1932x1916px. Color fundus photograph. FOV: 45 degrees: 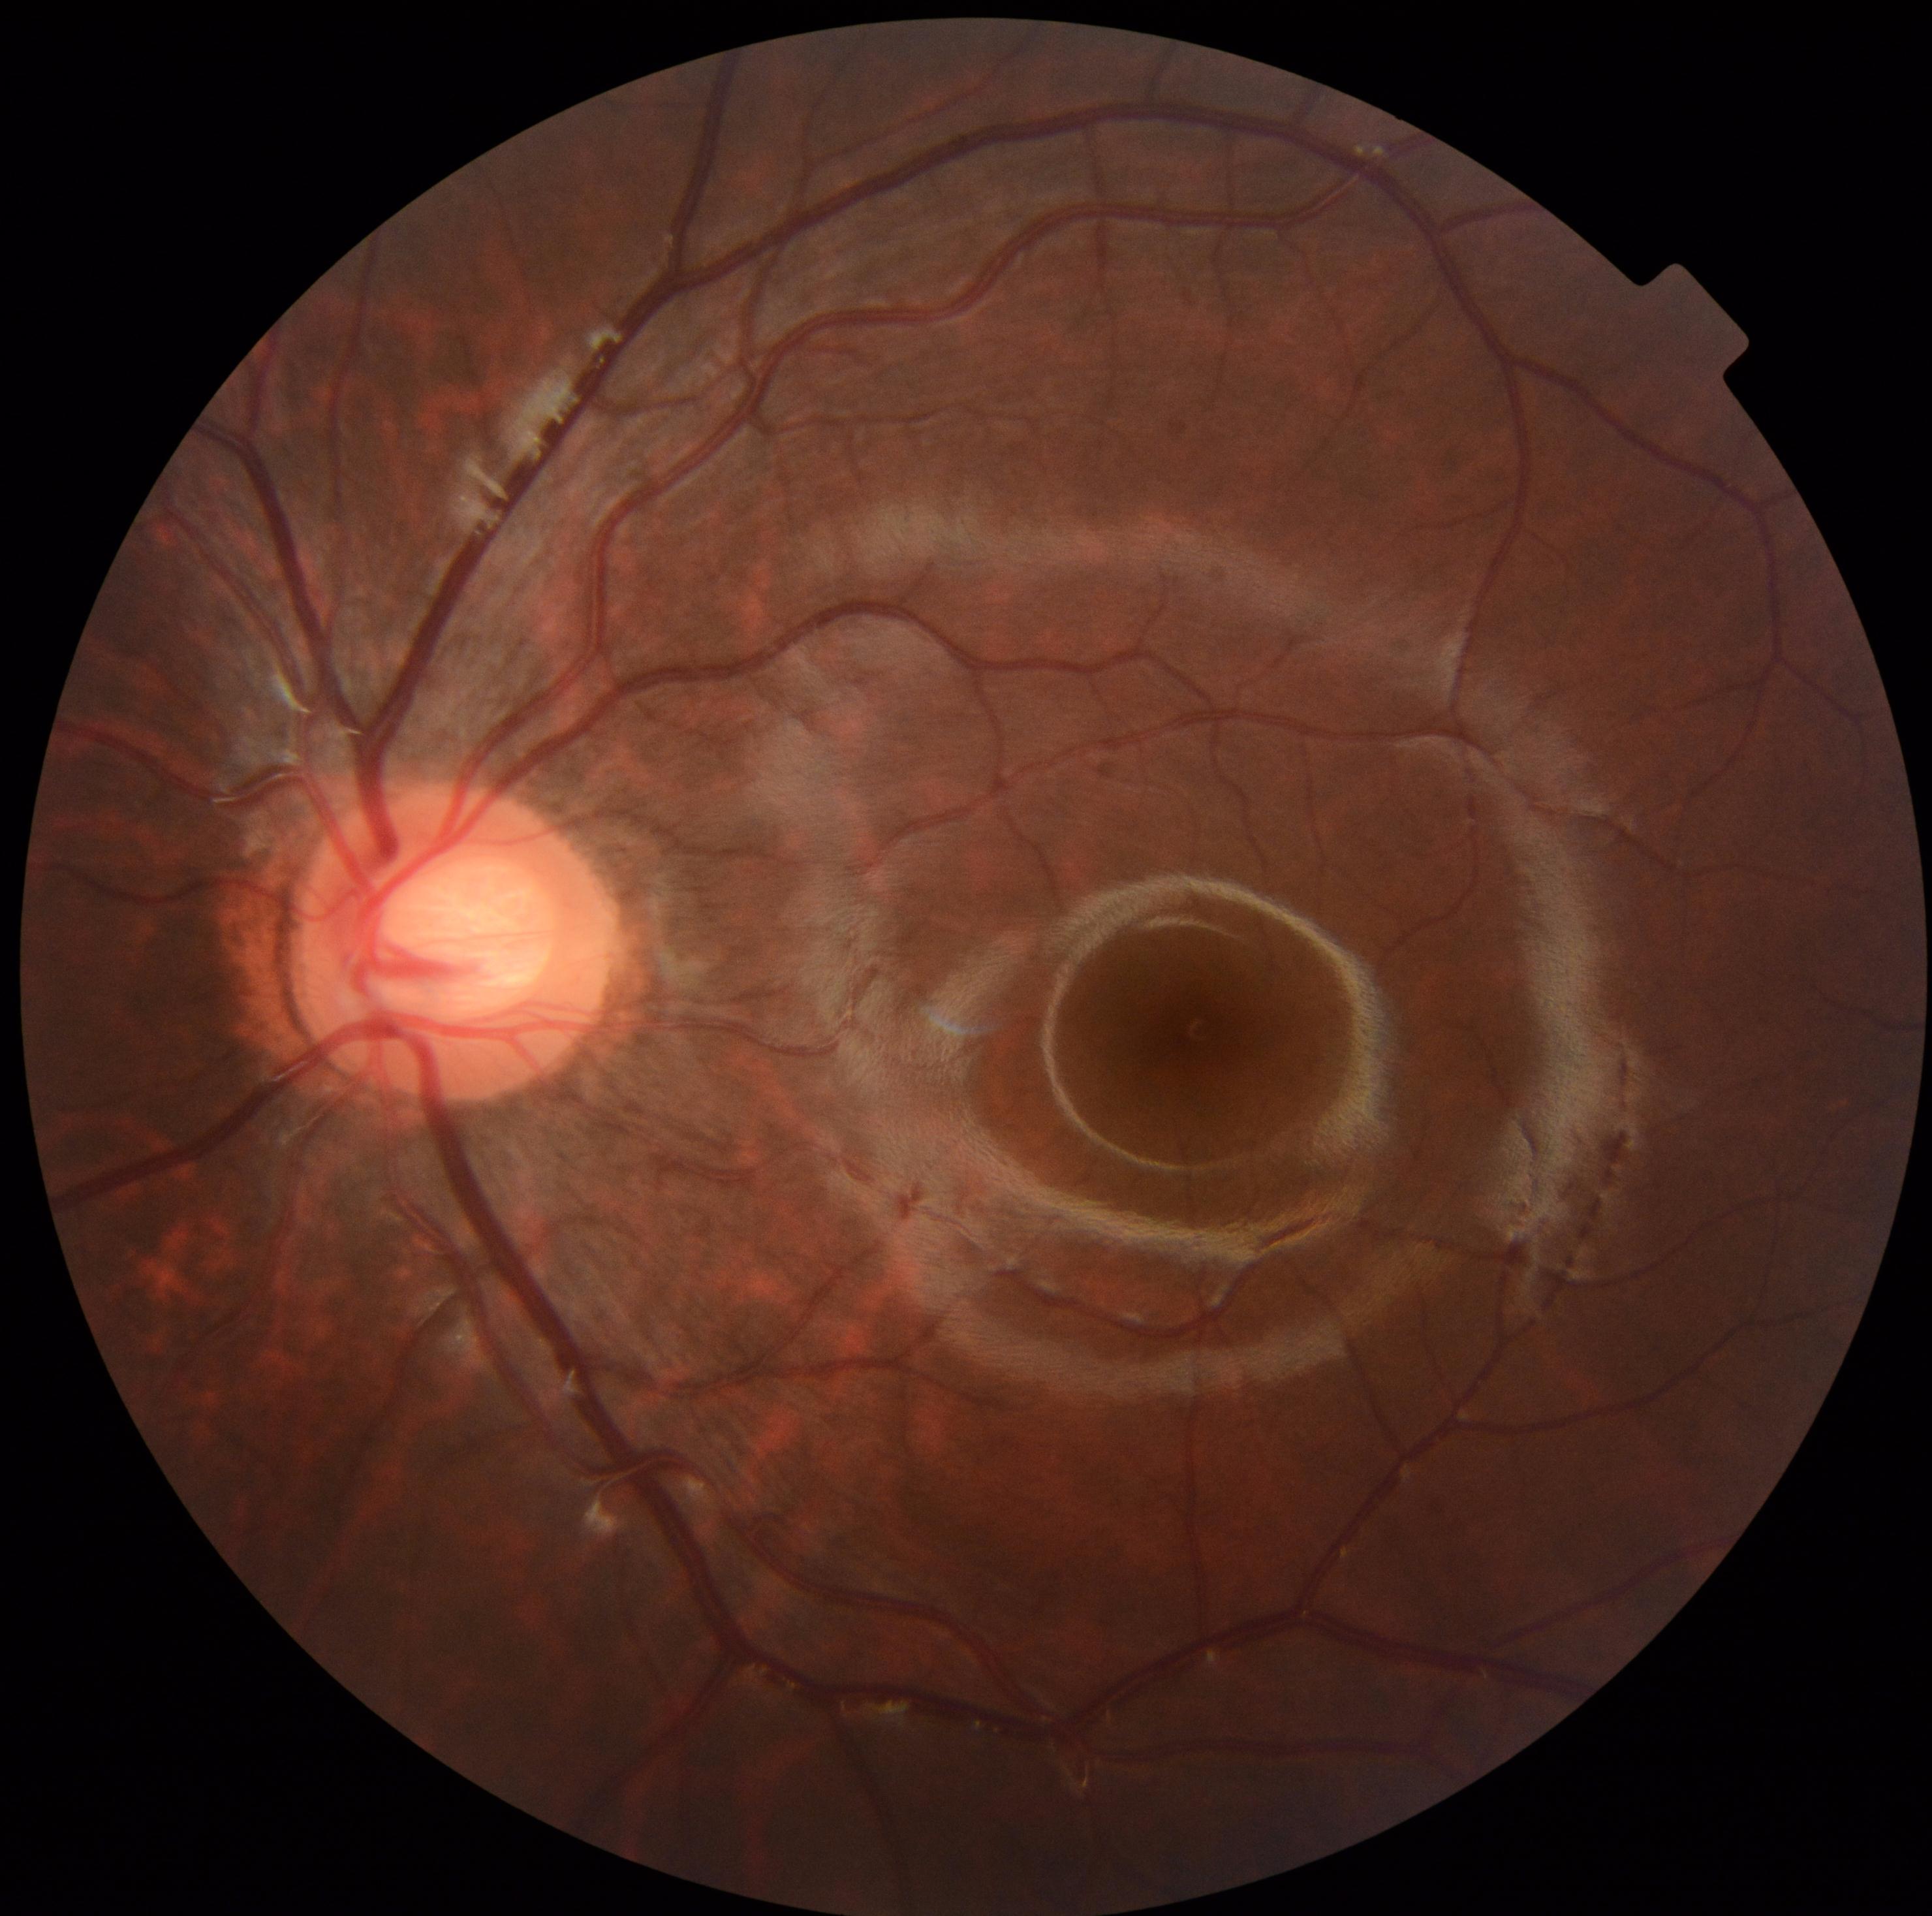 retinopathy: grade 0.